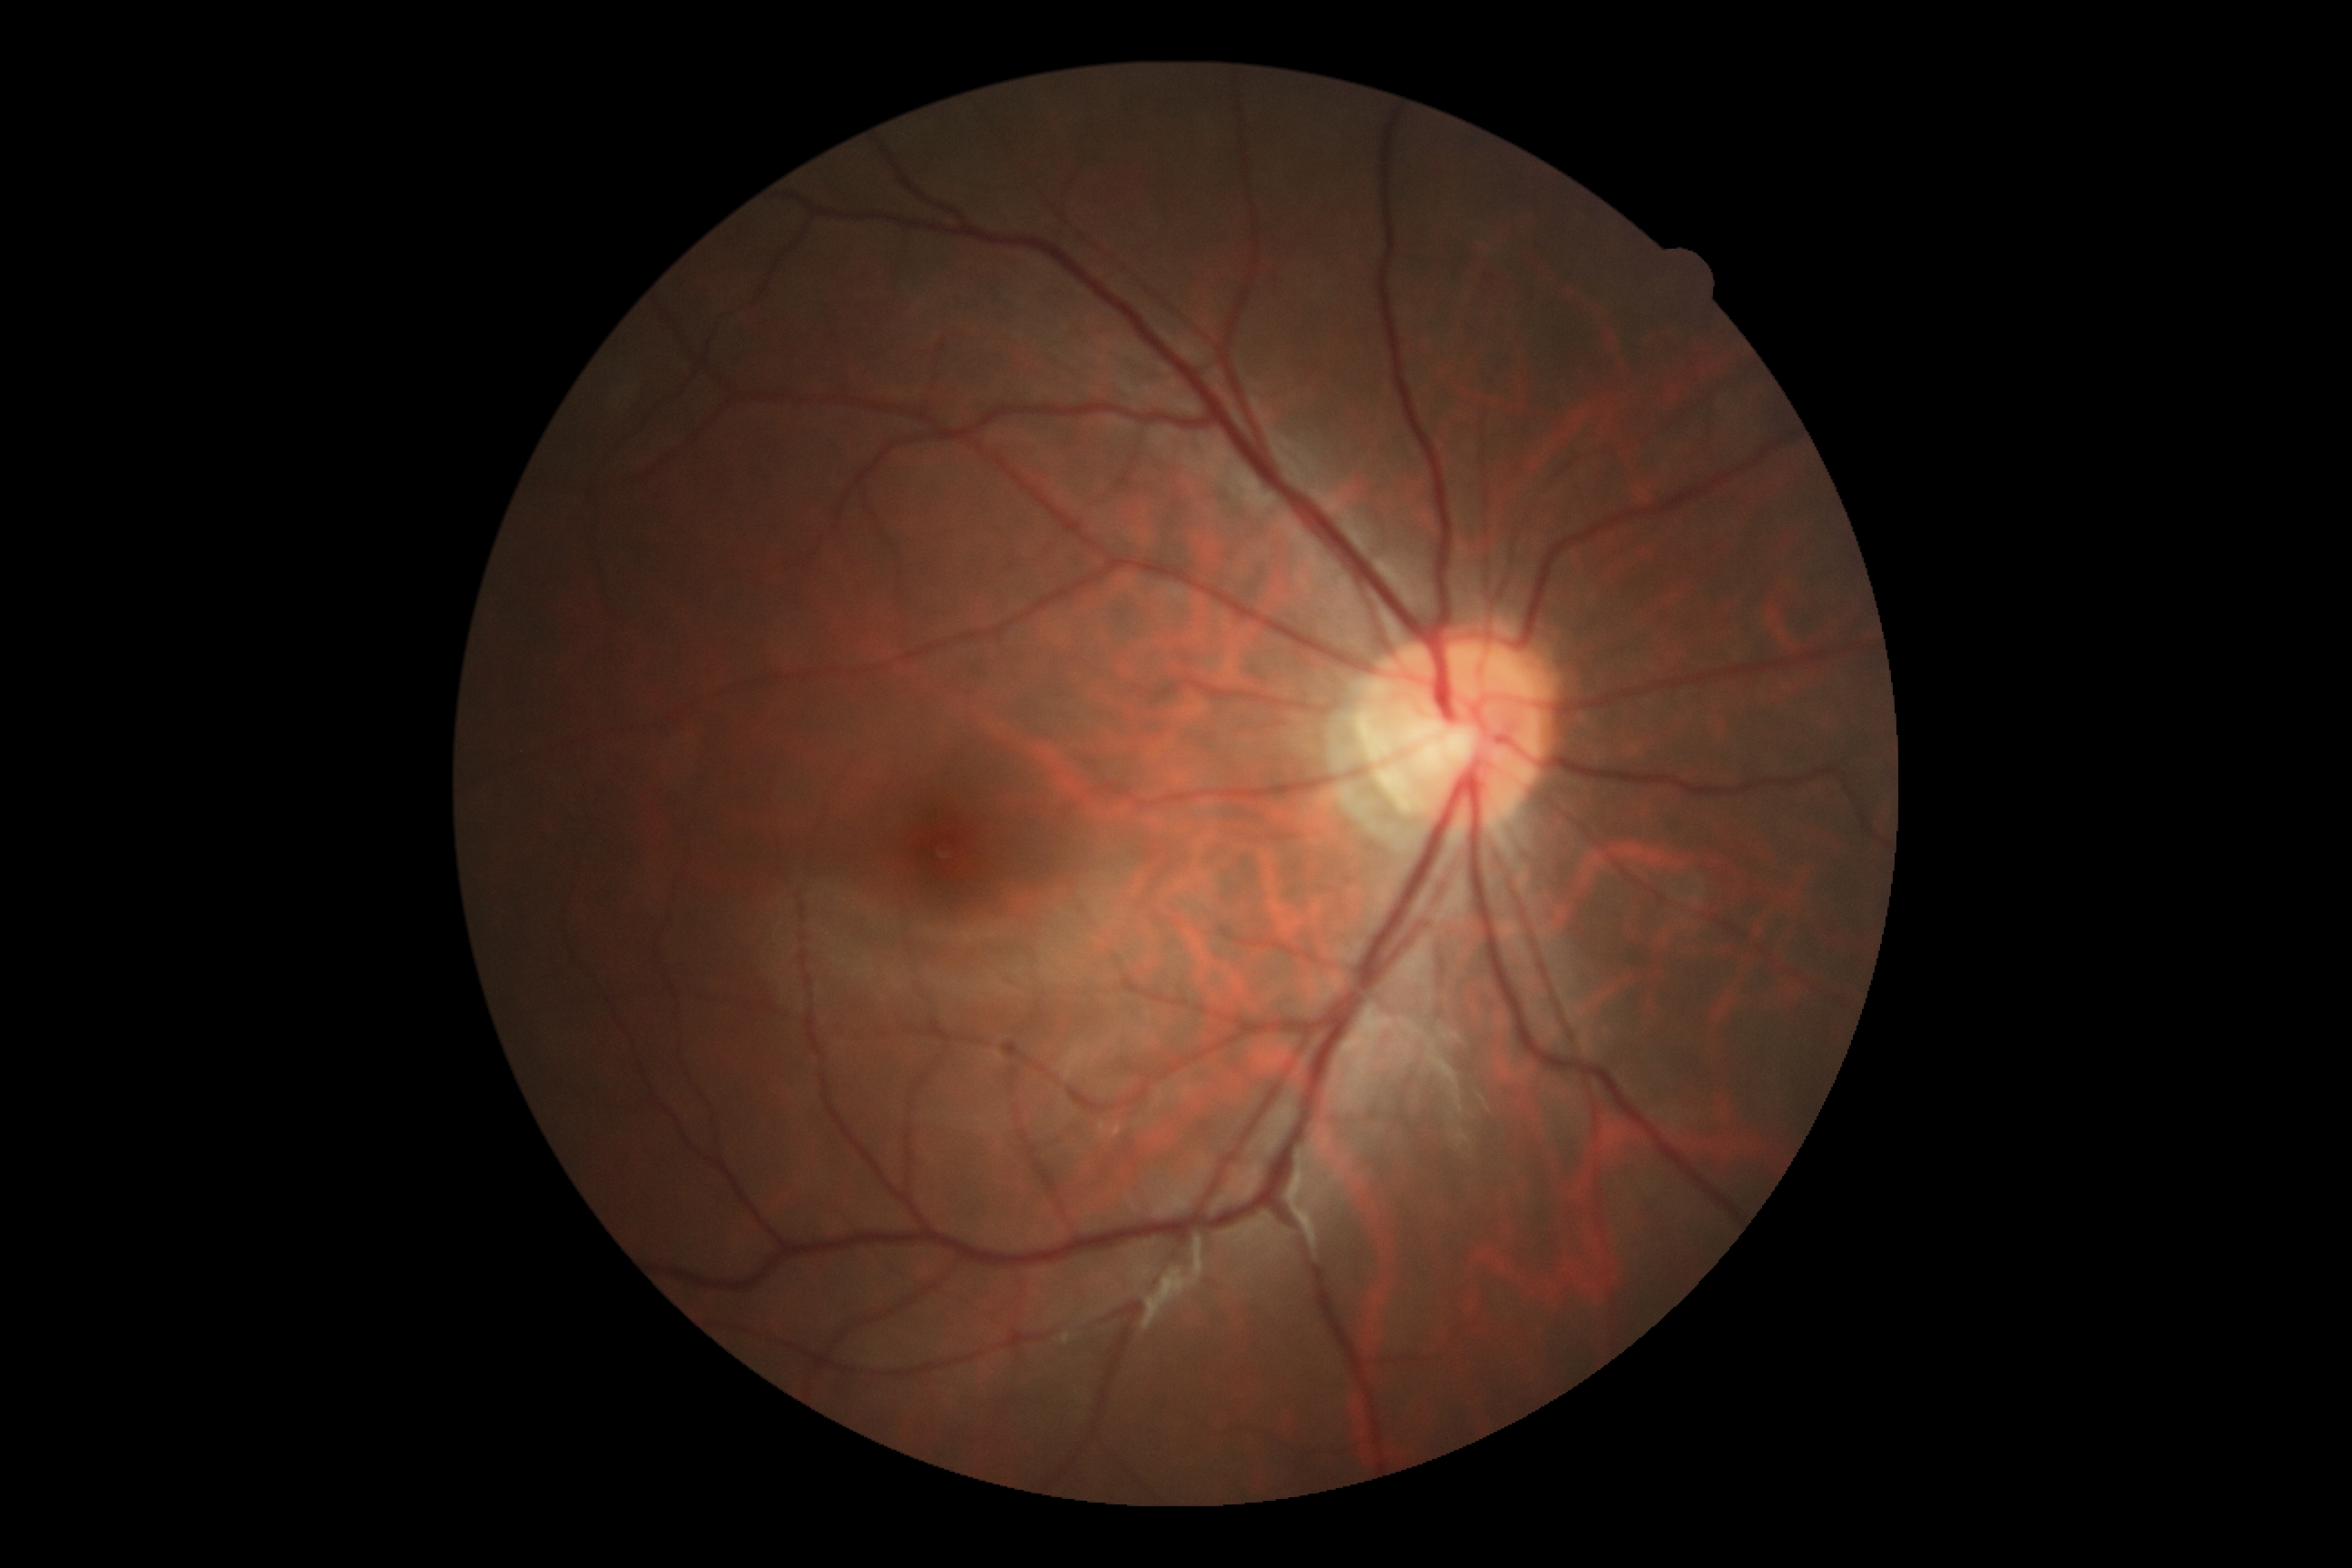 {"dr_grade": "grade 0"}